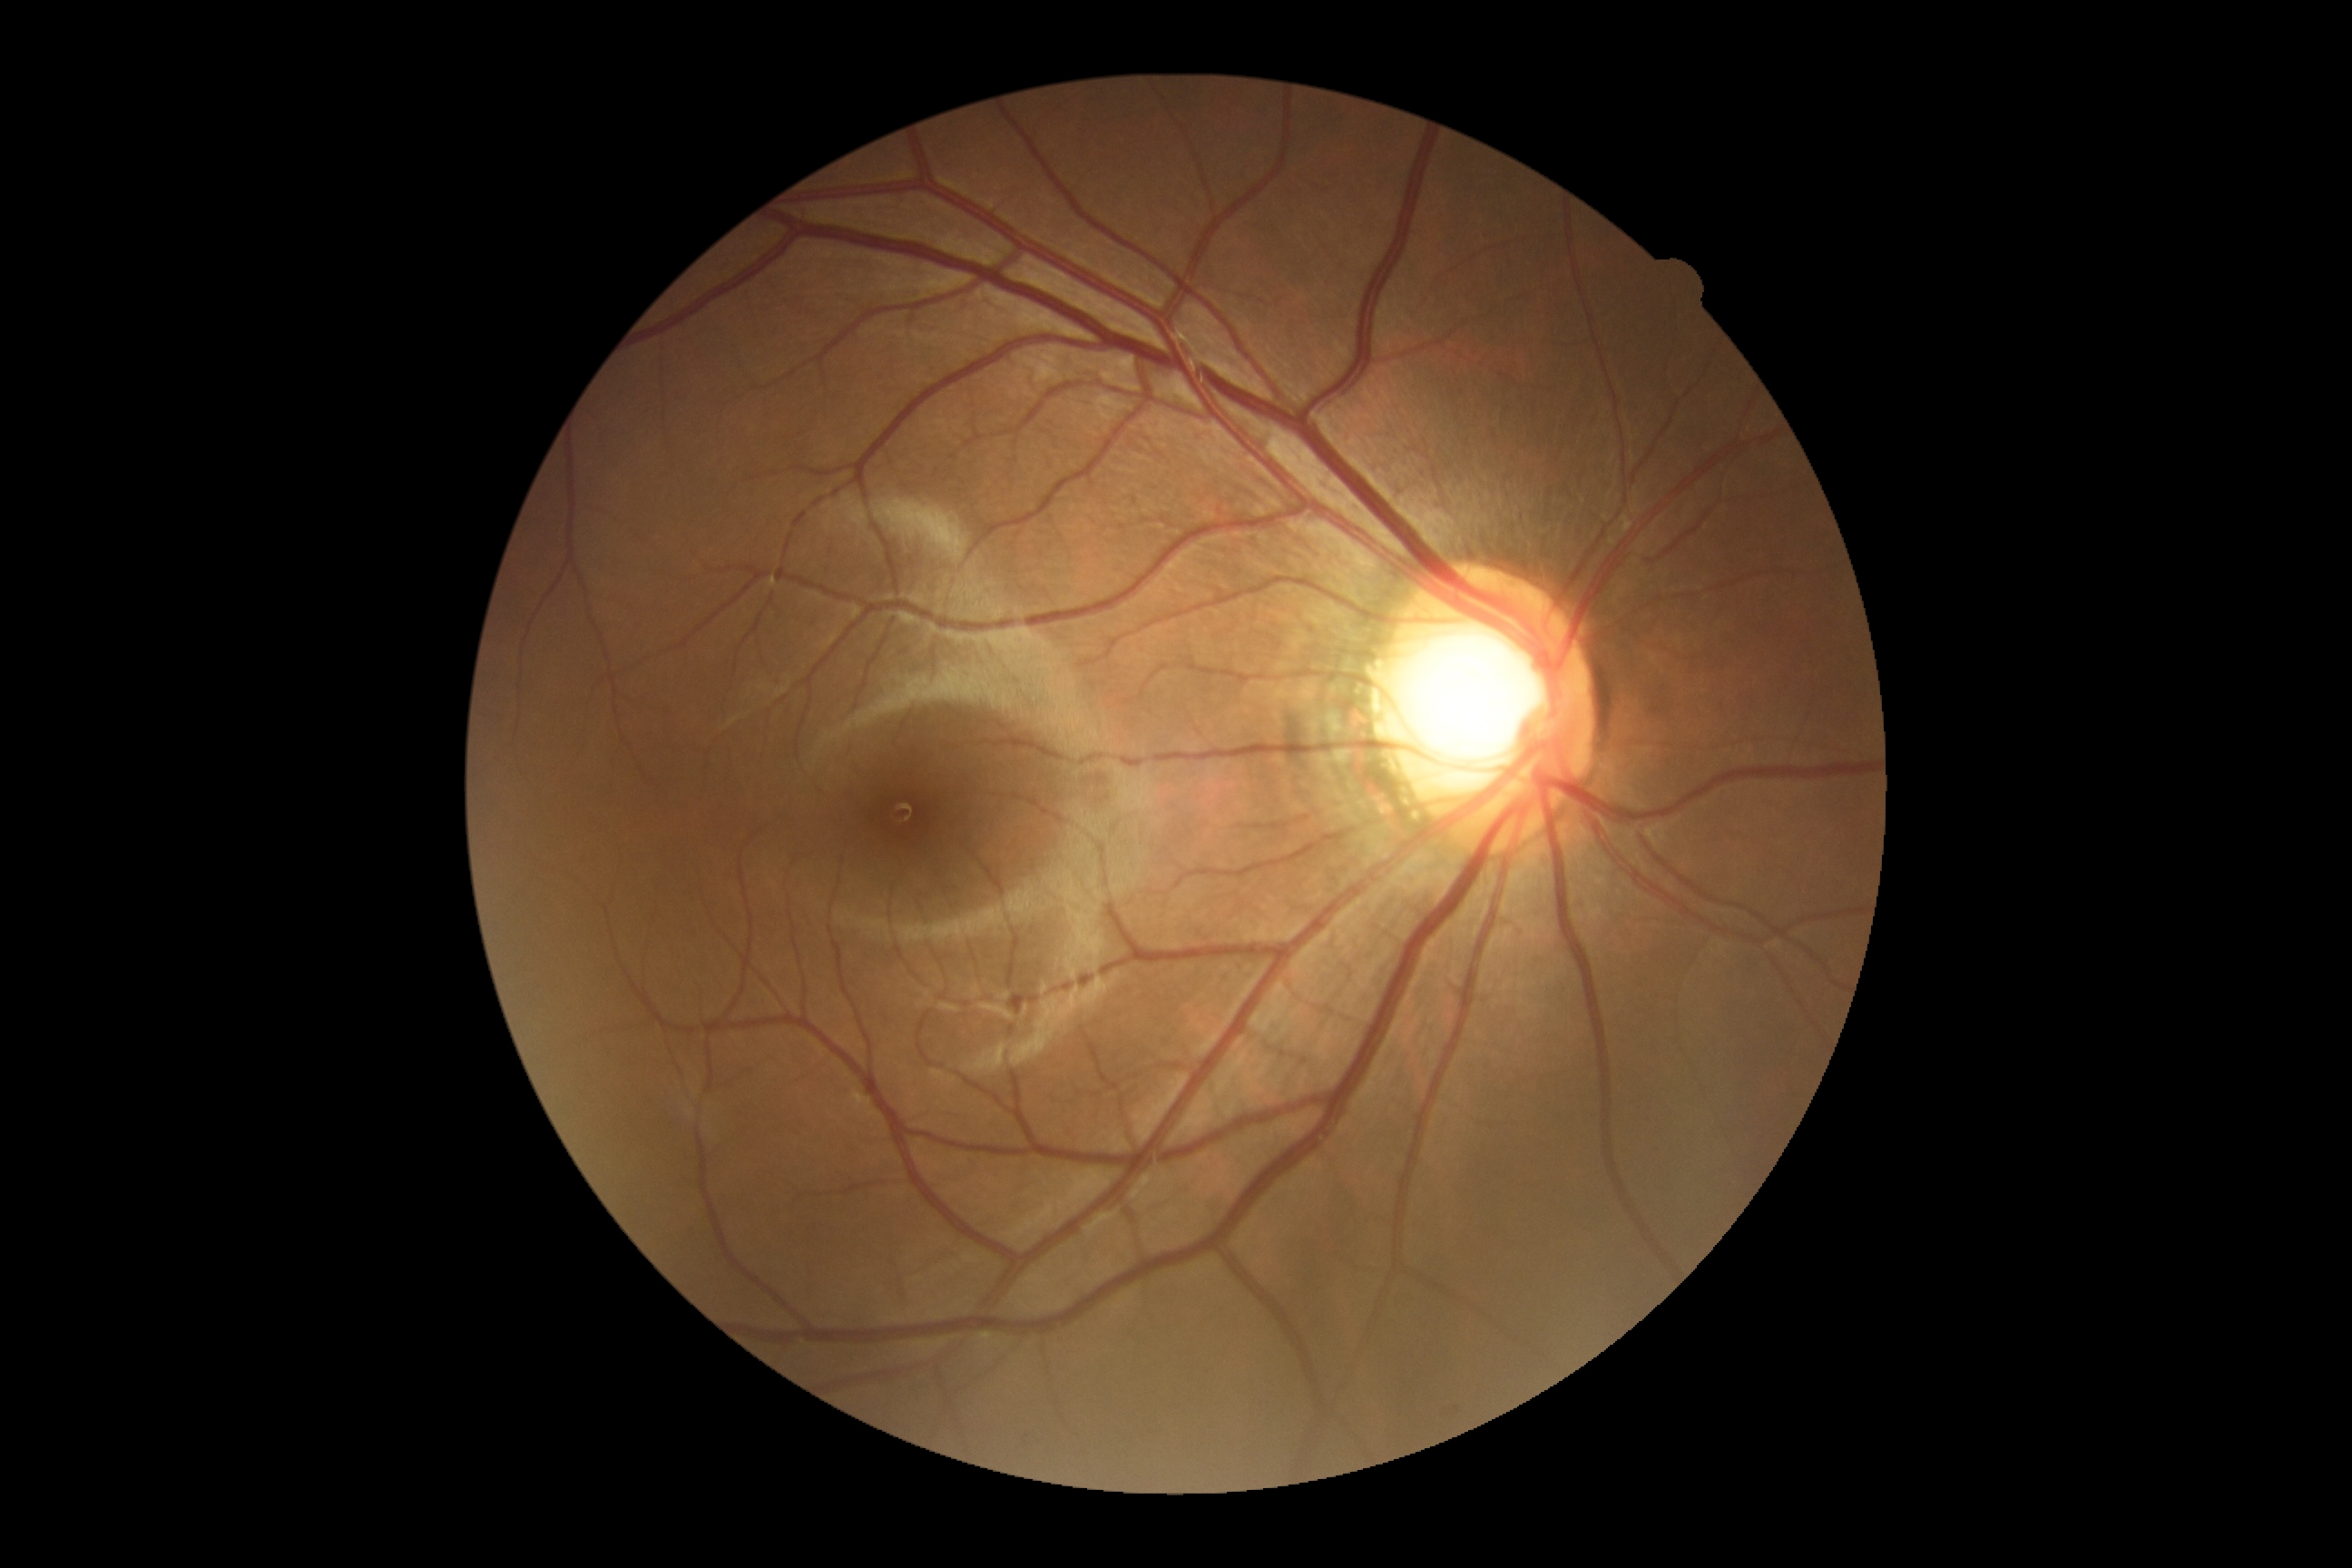 – DR: 0